Acquired with a NIDEK AFC-230: 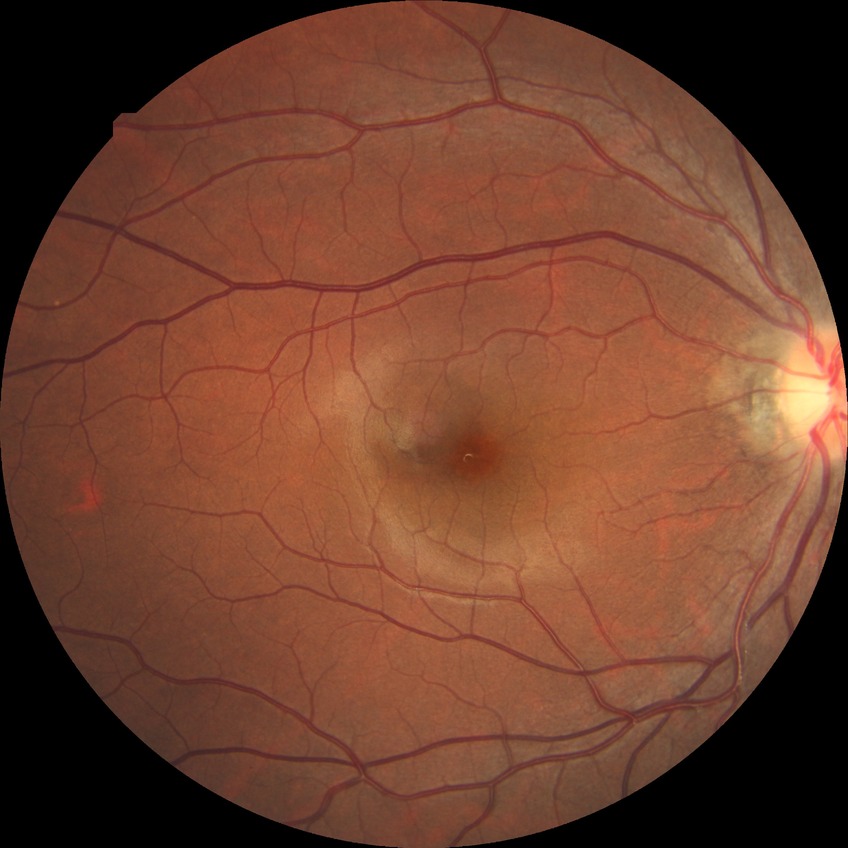
{
  "davis_grade": "NDR (no diabetic retinopathy)"
}